Central posterior field
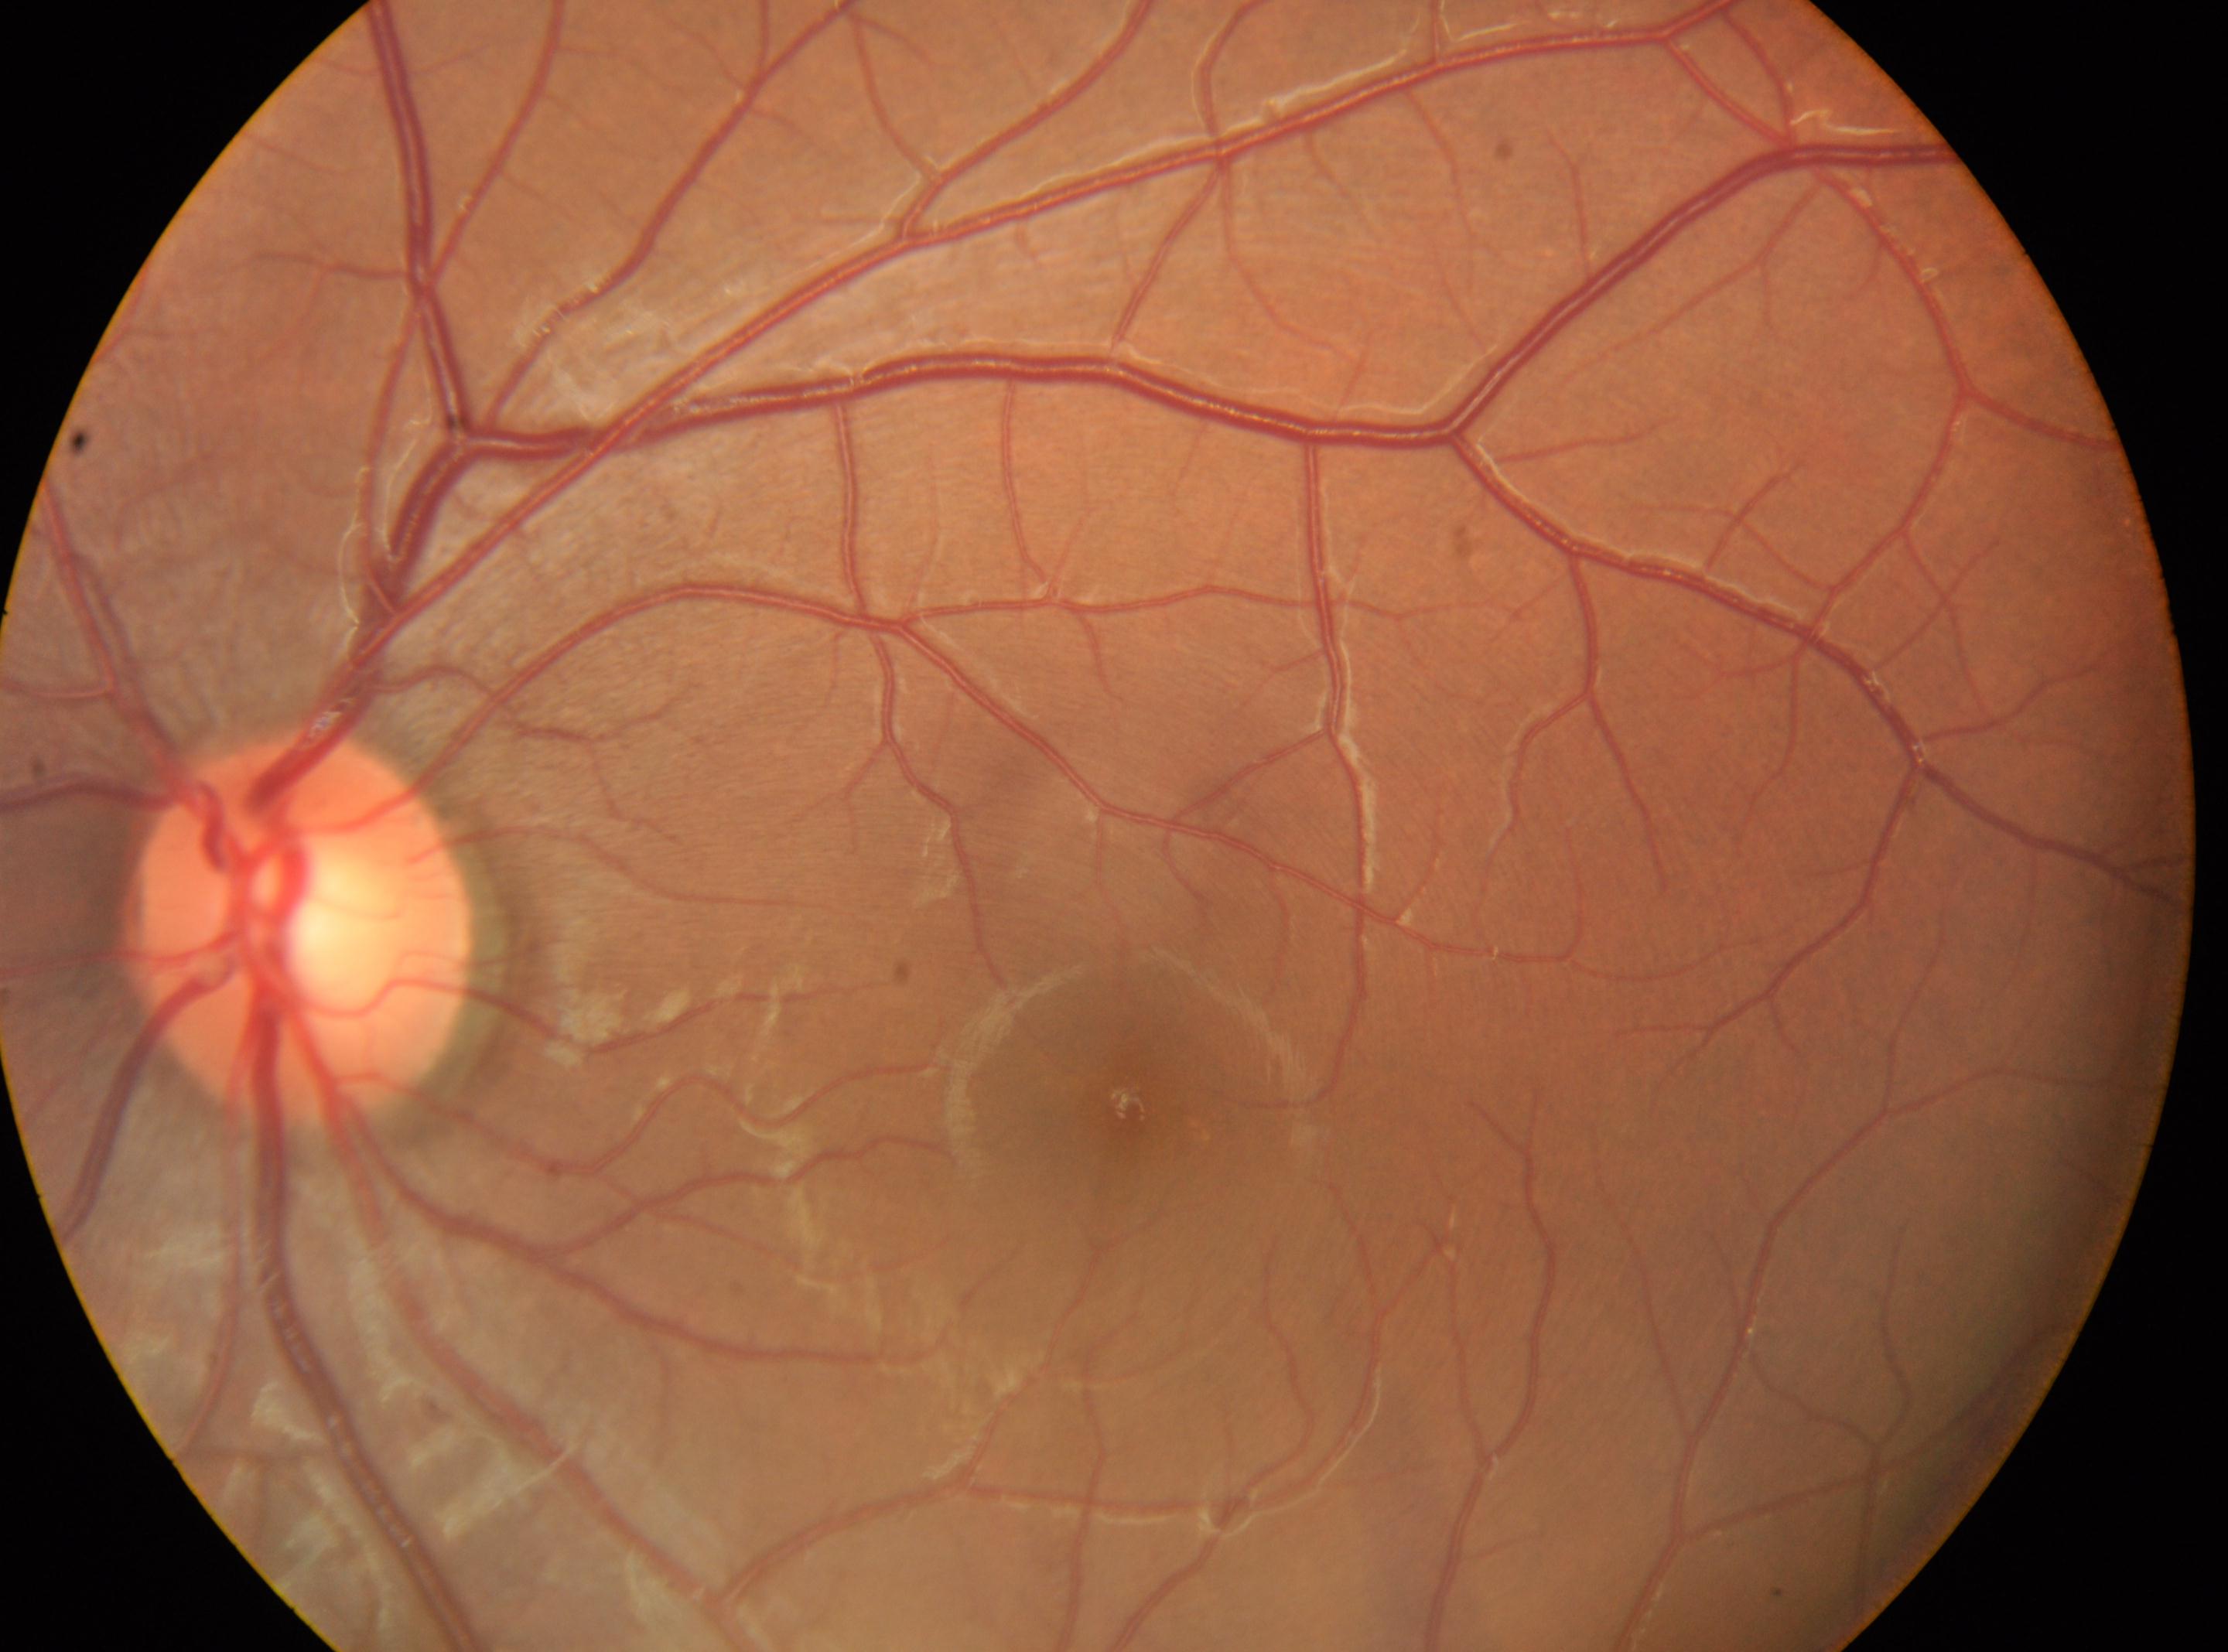 Diabetic retinopathy grade: 0. Eye: left eye. No apparent diabetic retinopathy. The disc center is at 300, 931. Fovea center located at 1131, 1109.